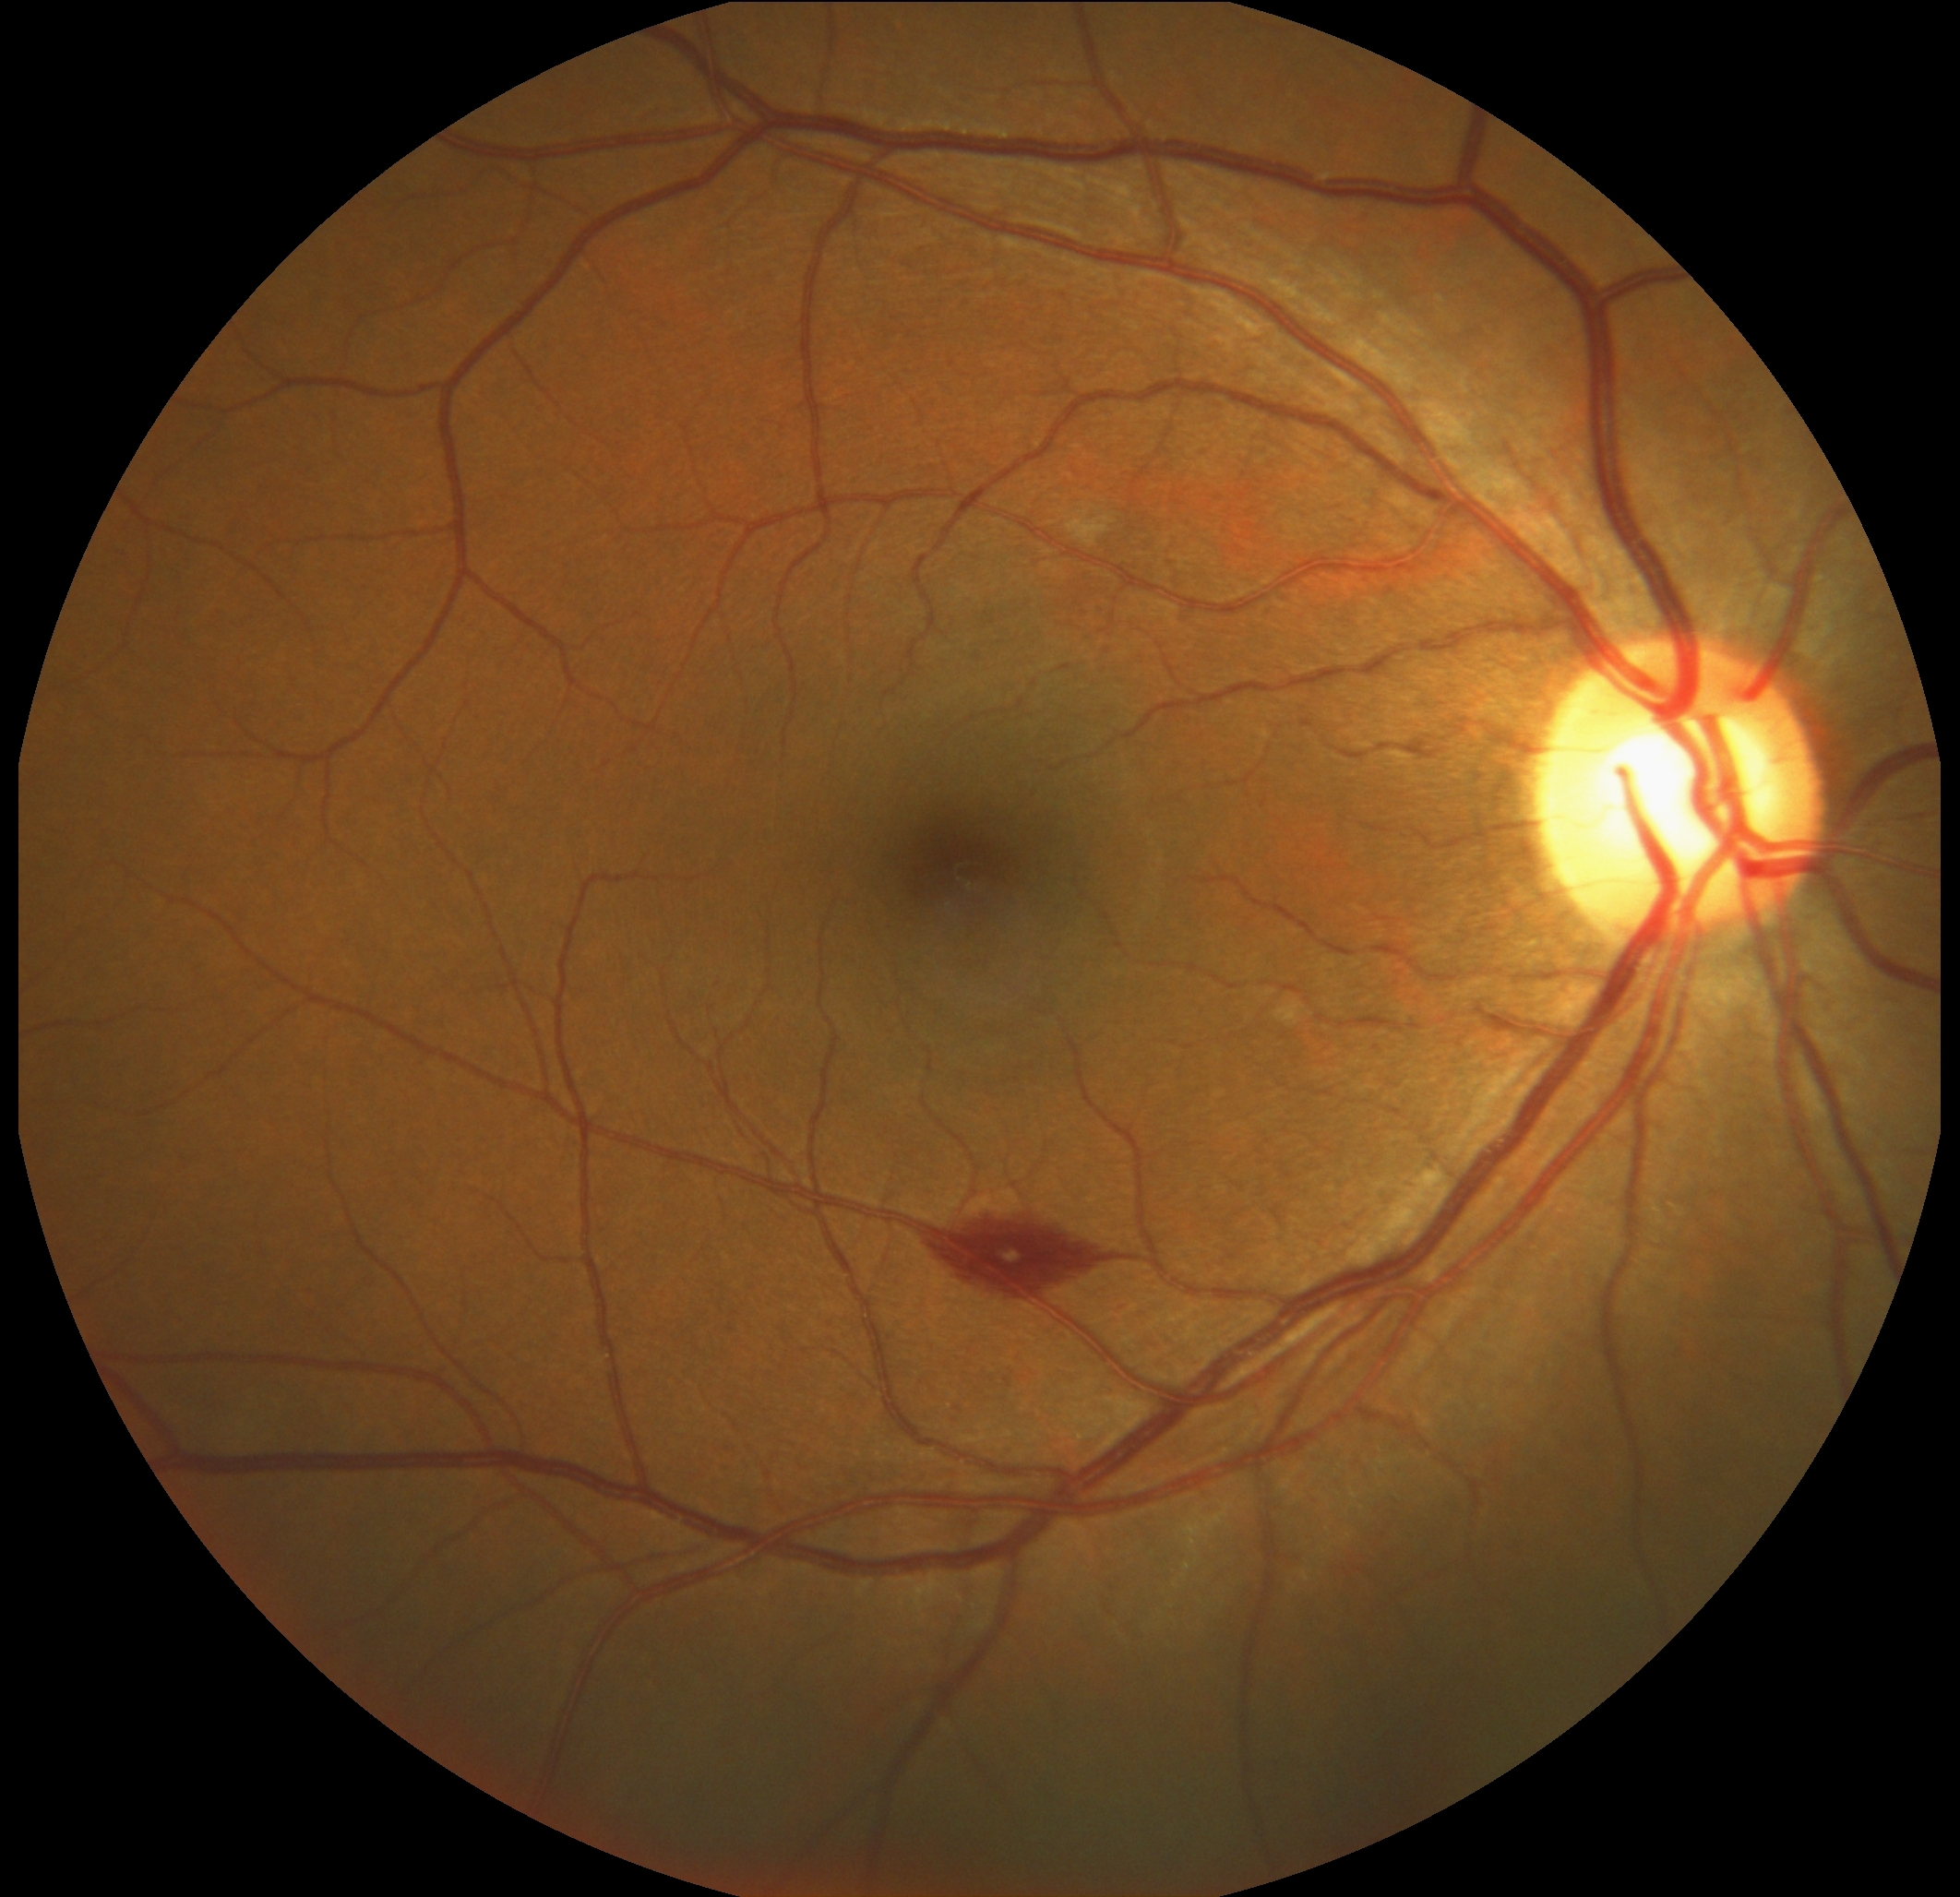

Diabetic retinopathy (DR) is moderate NPDR (grade 2).